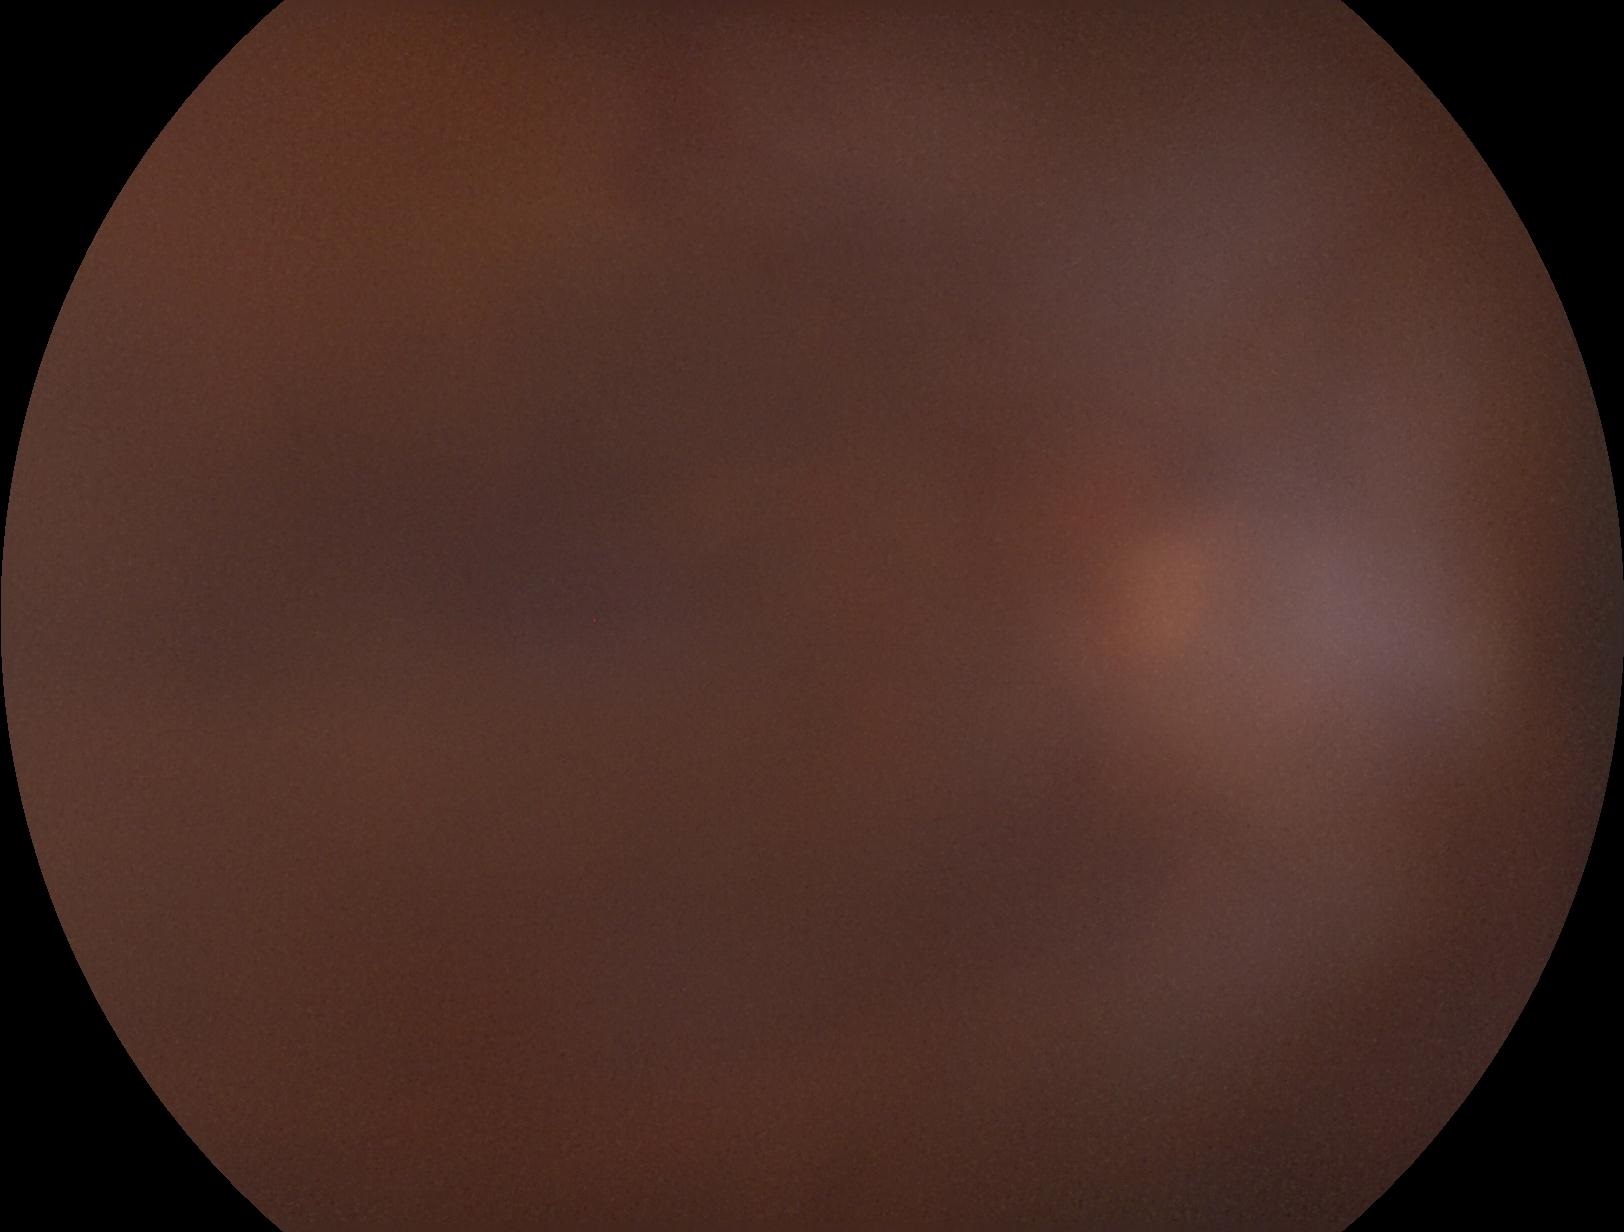
Diabetic retinopathy (DR): ungradable due to poor image quality.